2361x1568.
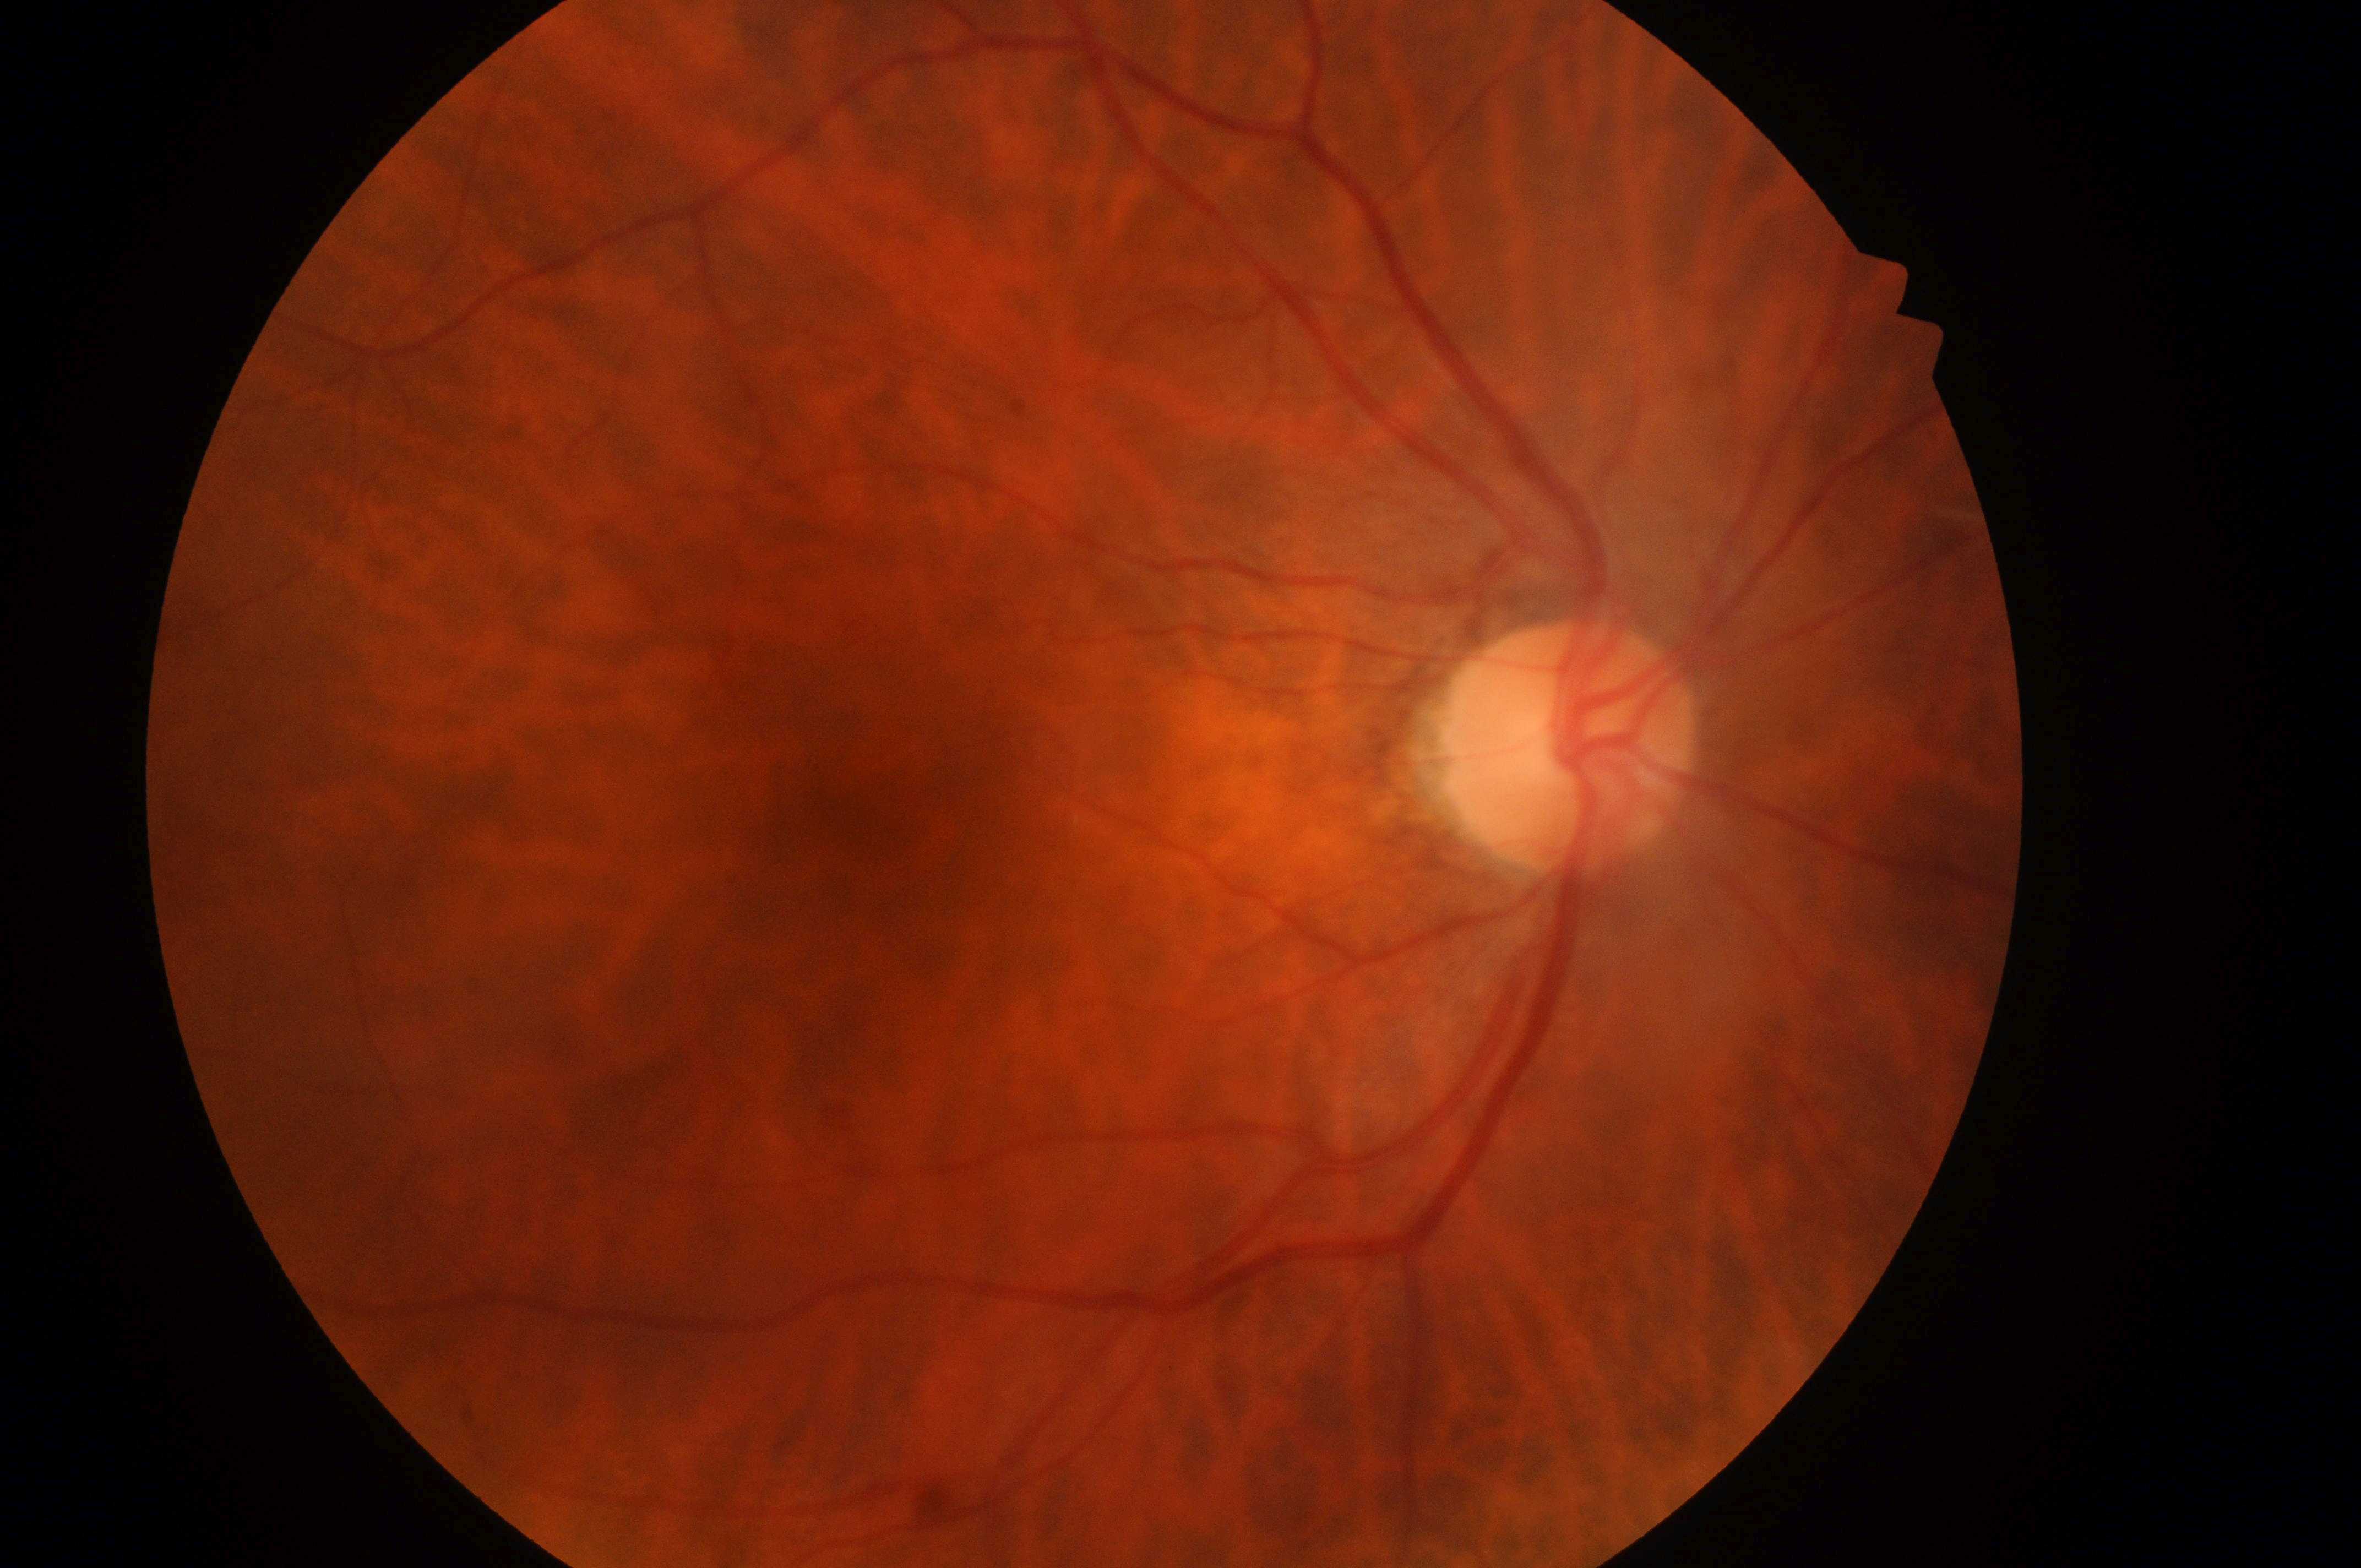
  dr_grade: 0/4
  dme_grade: 0
  fovea: 910, 829
  eye: oculus dexter
  optic_disc: 1559, 750
  dr_impression: No apparent diabetic retinopathy or macular edema